Color fundus photograph · 45° FOV · 2144 x 1424 pixels
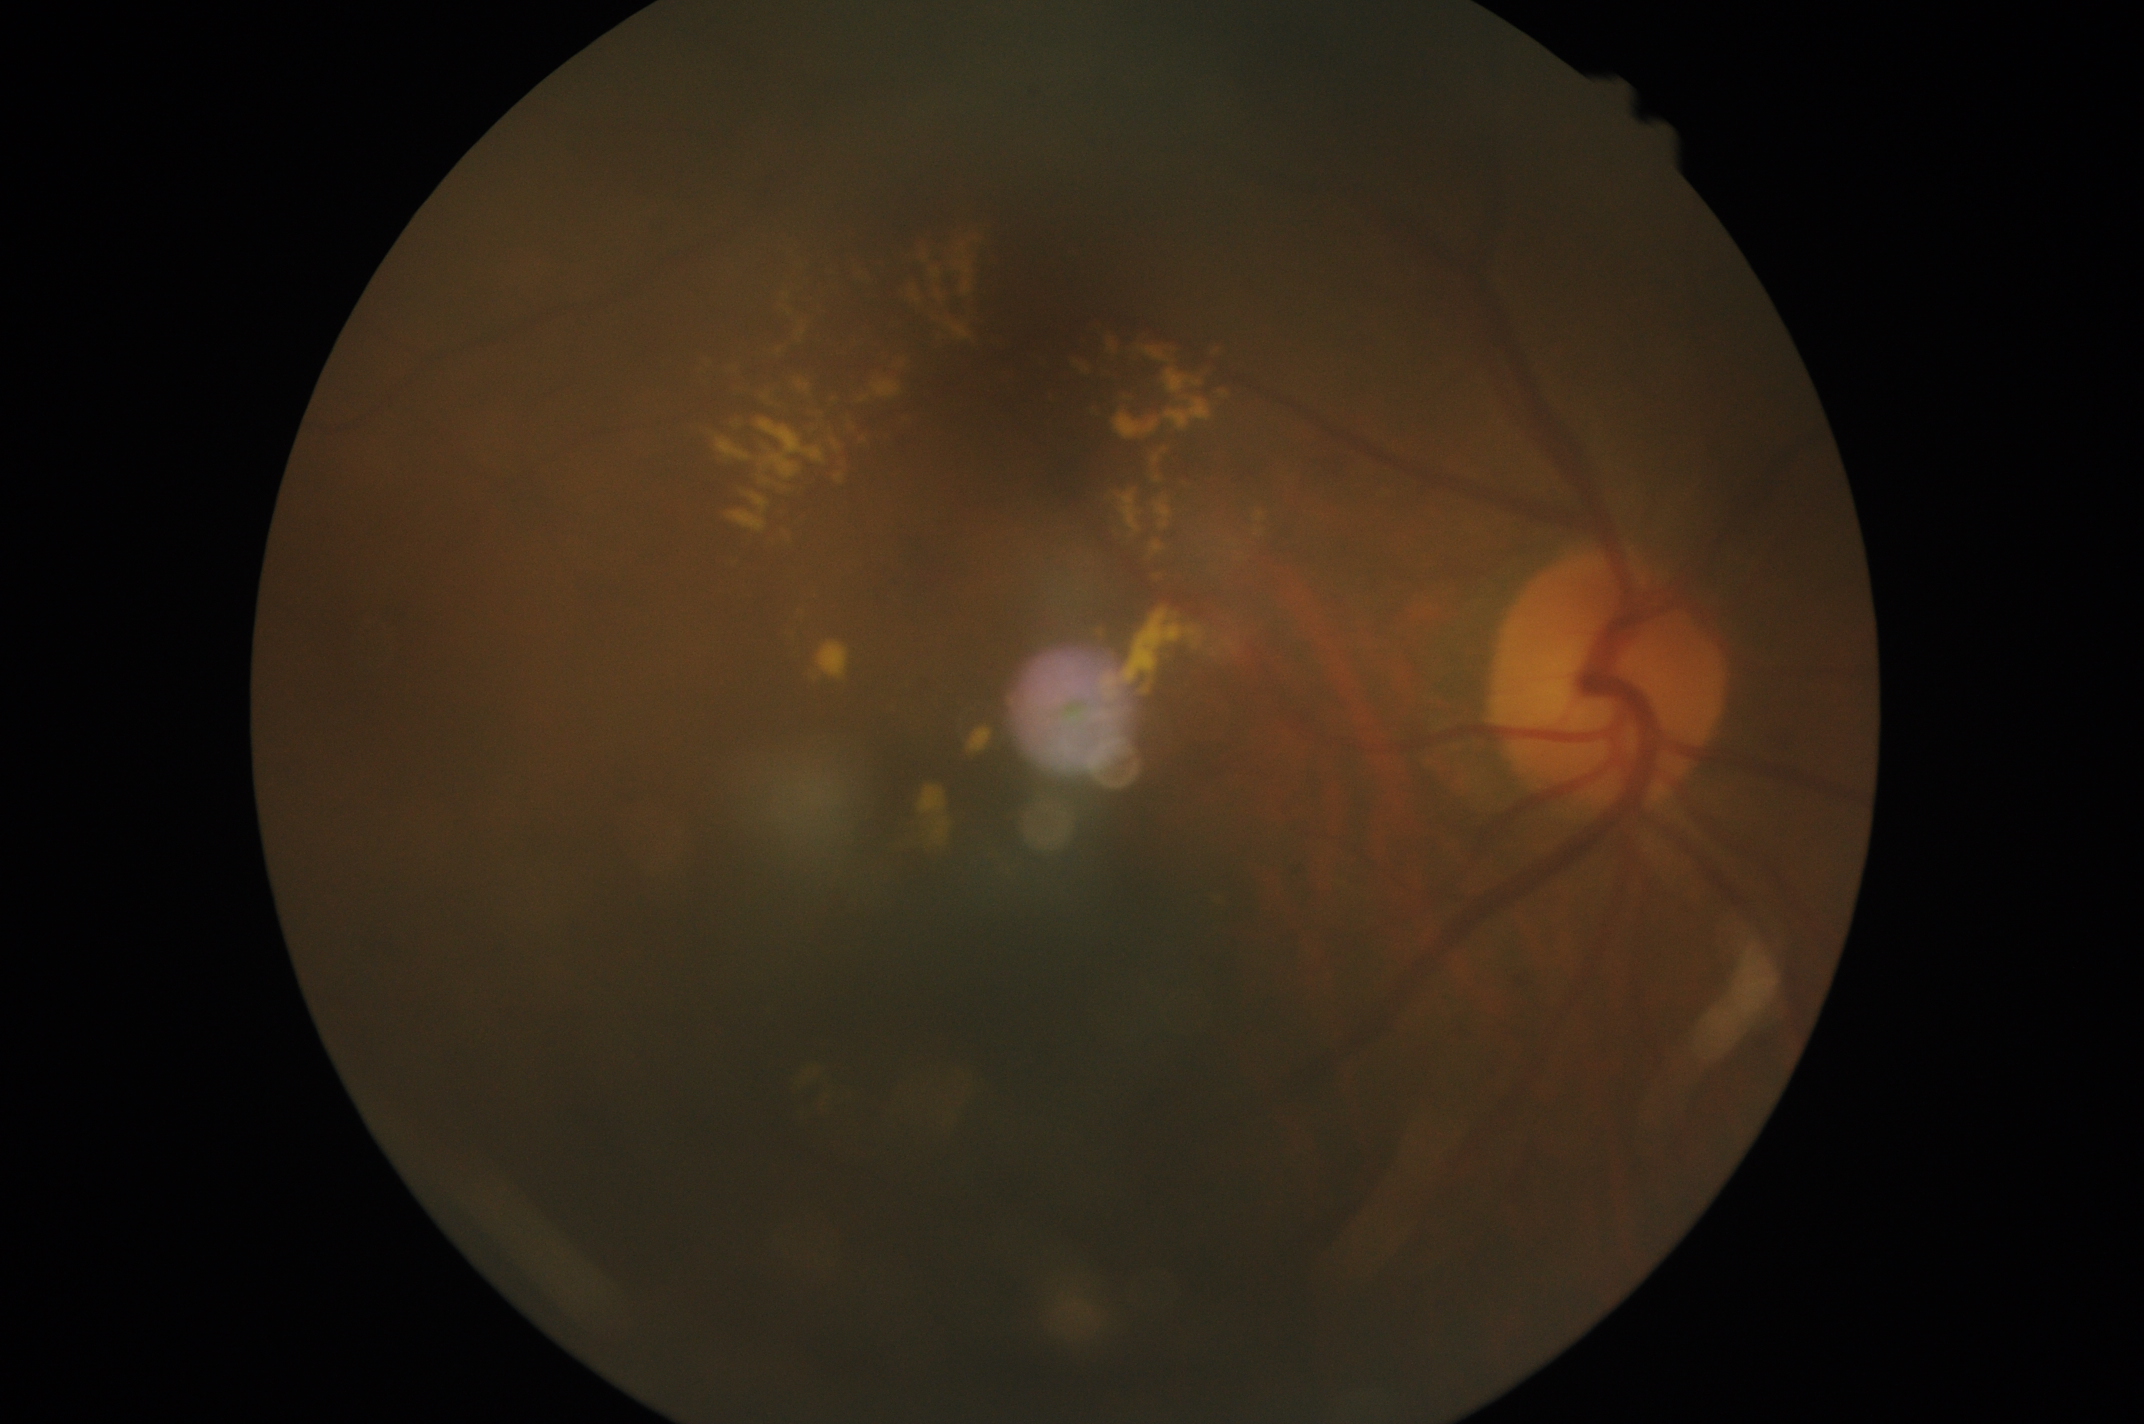

retinopathy = moderate non-proliferative diabetic retinopathy (grade 2) — more than just microaneurysms but less than severe NPDR.